2352x1568 · 45° field of view: 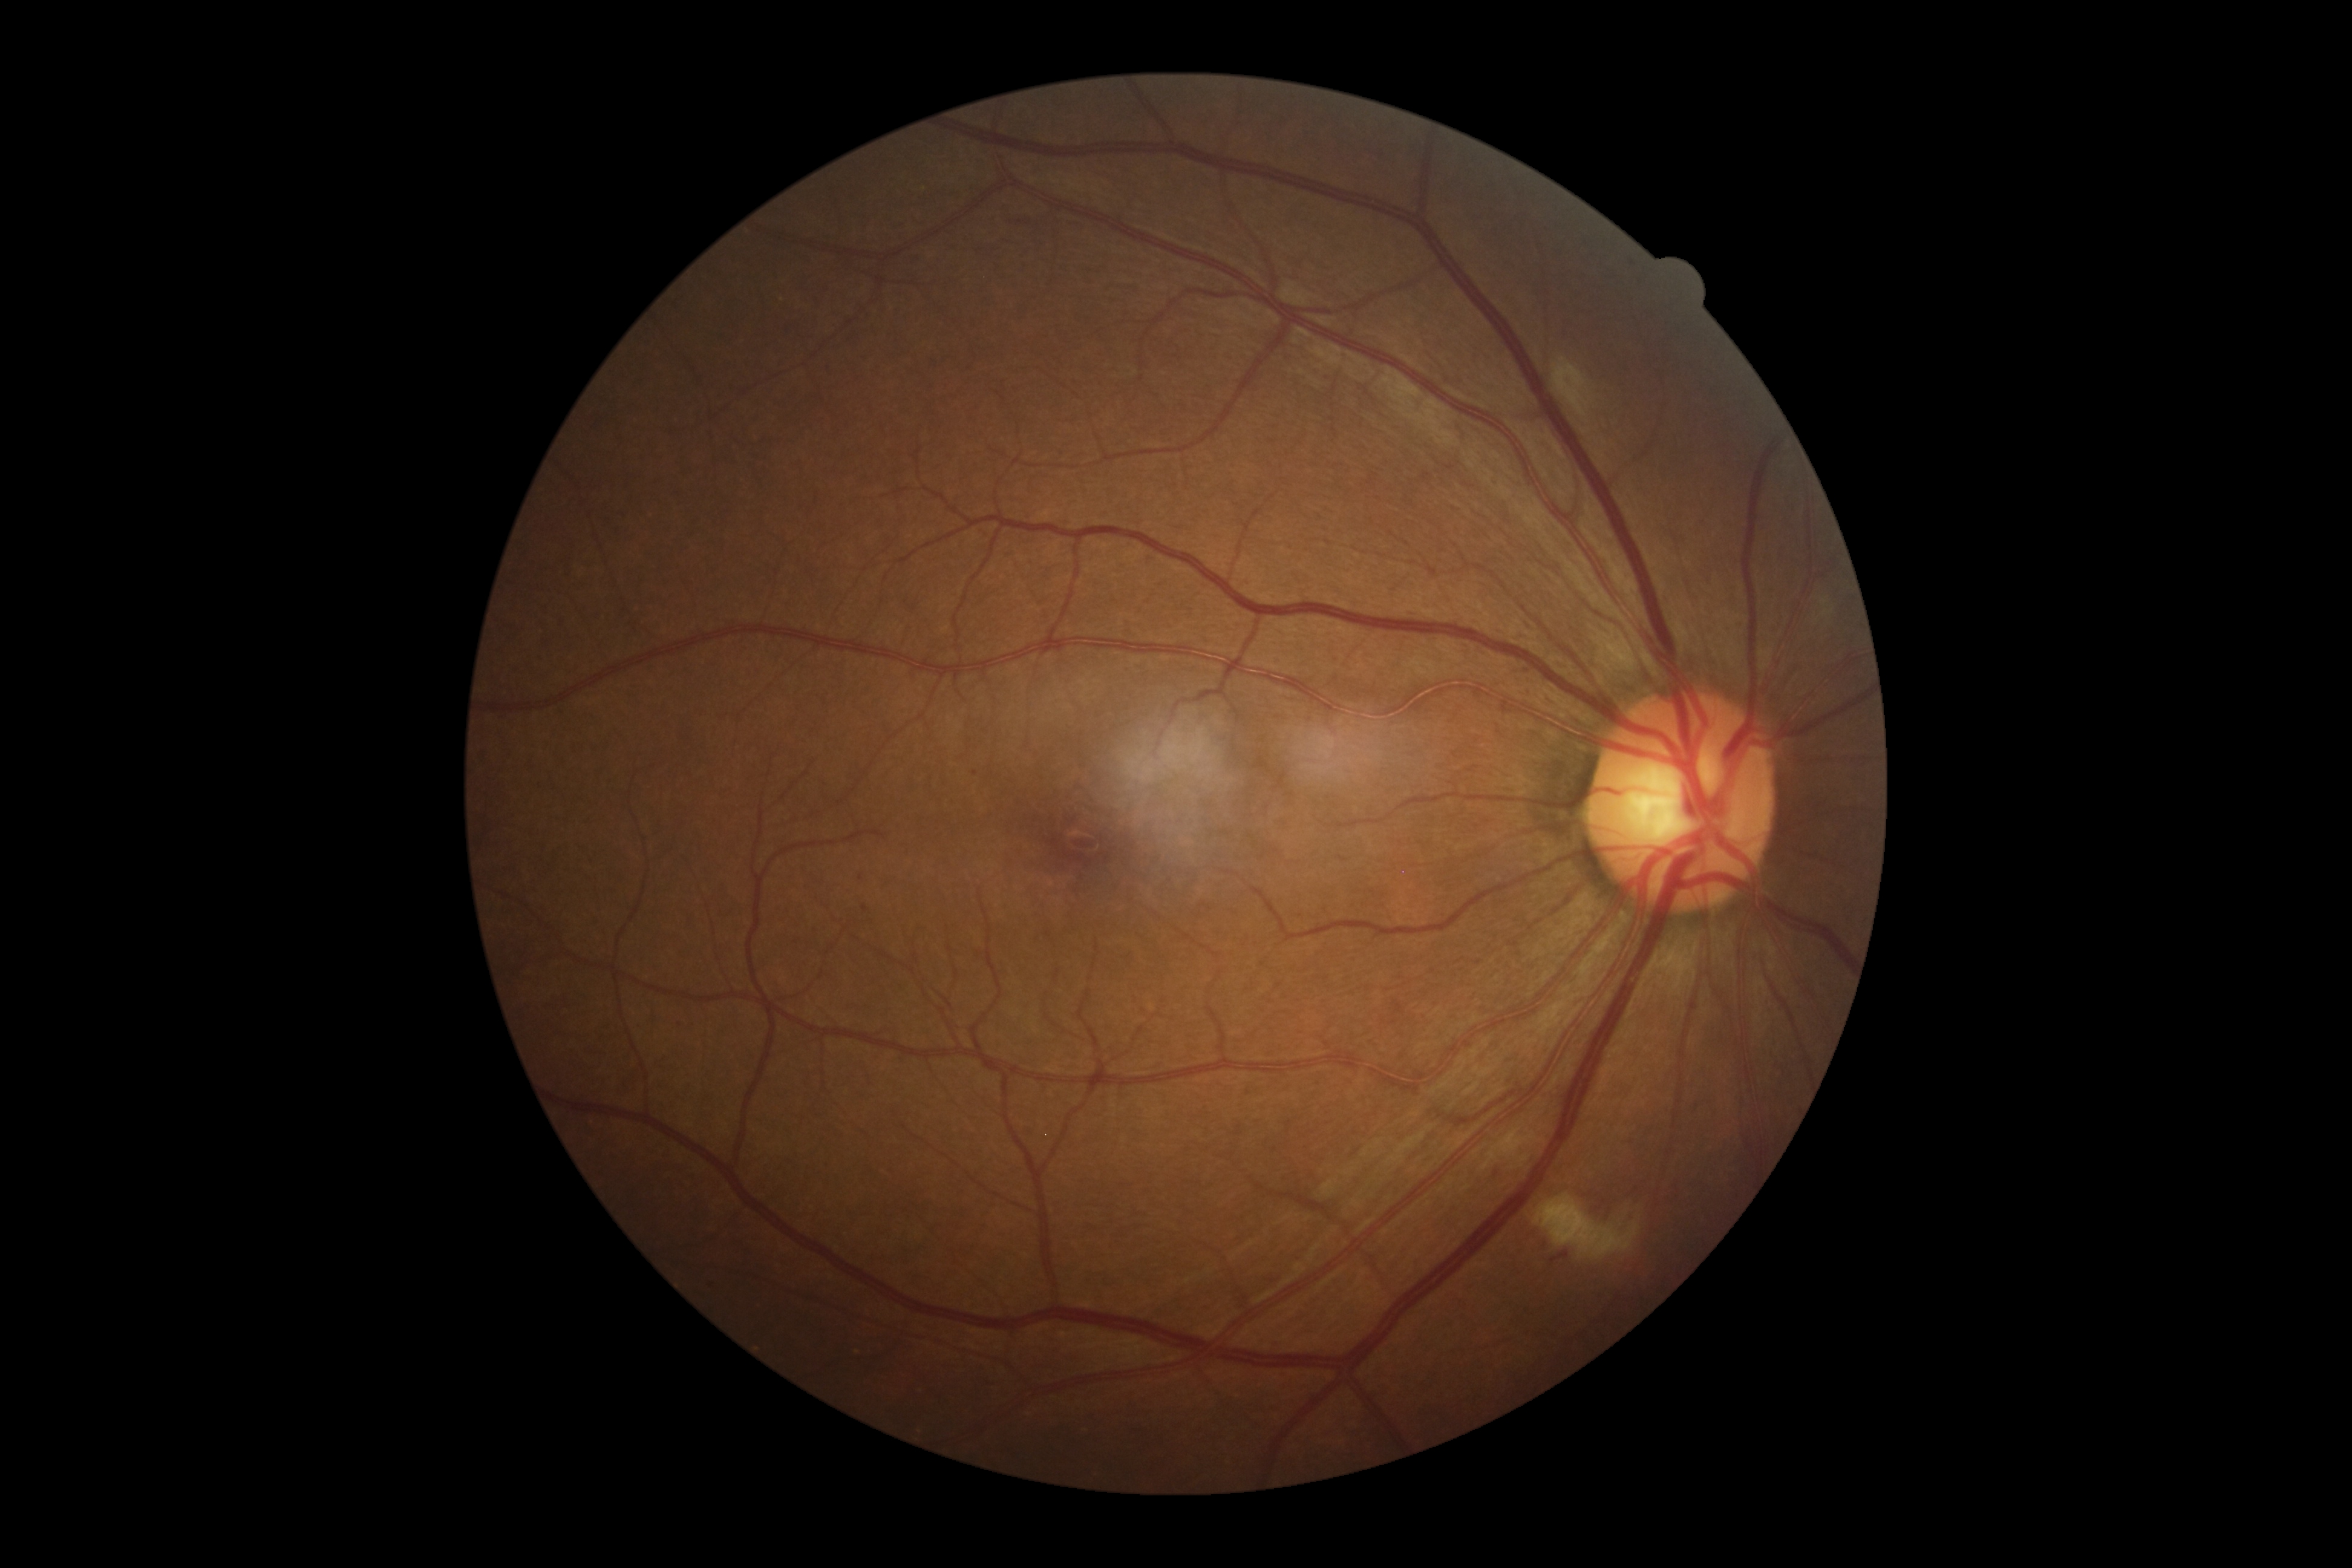
Diabetic retinopathy grade: 2 (moderate NPDR) — more than just microaneurysms but less than severe NPDR.